848x848 · color fundus image — 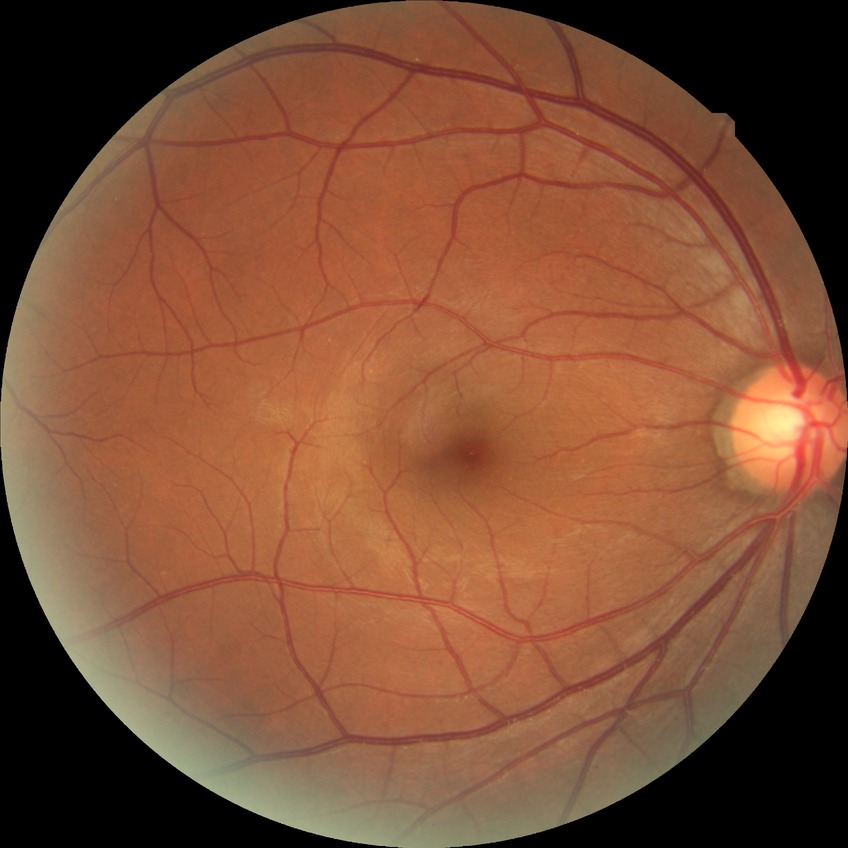 Findings:
• modified Davis grading: no diabetic retinopathy